Retinal fundus photograph · 45° FOV:
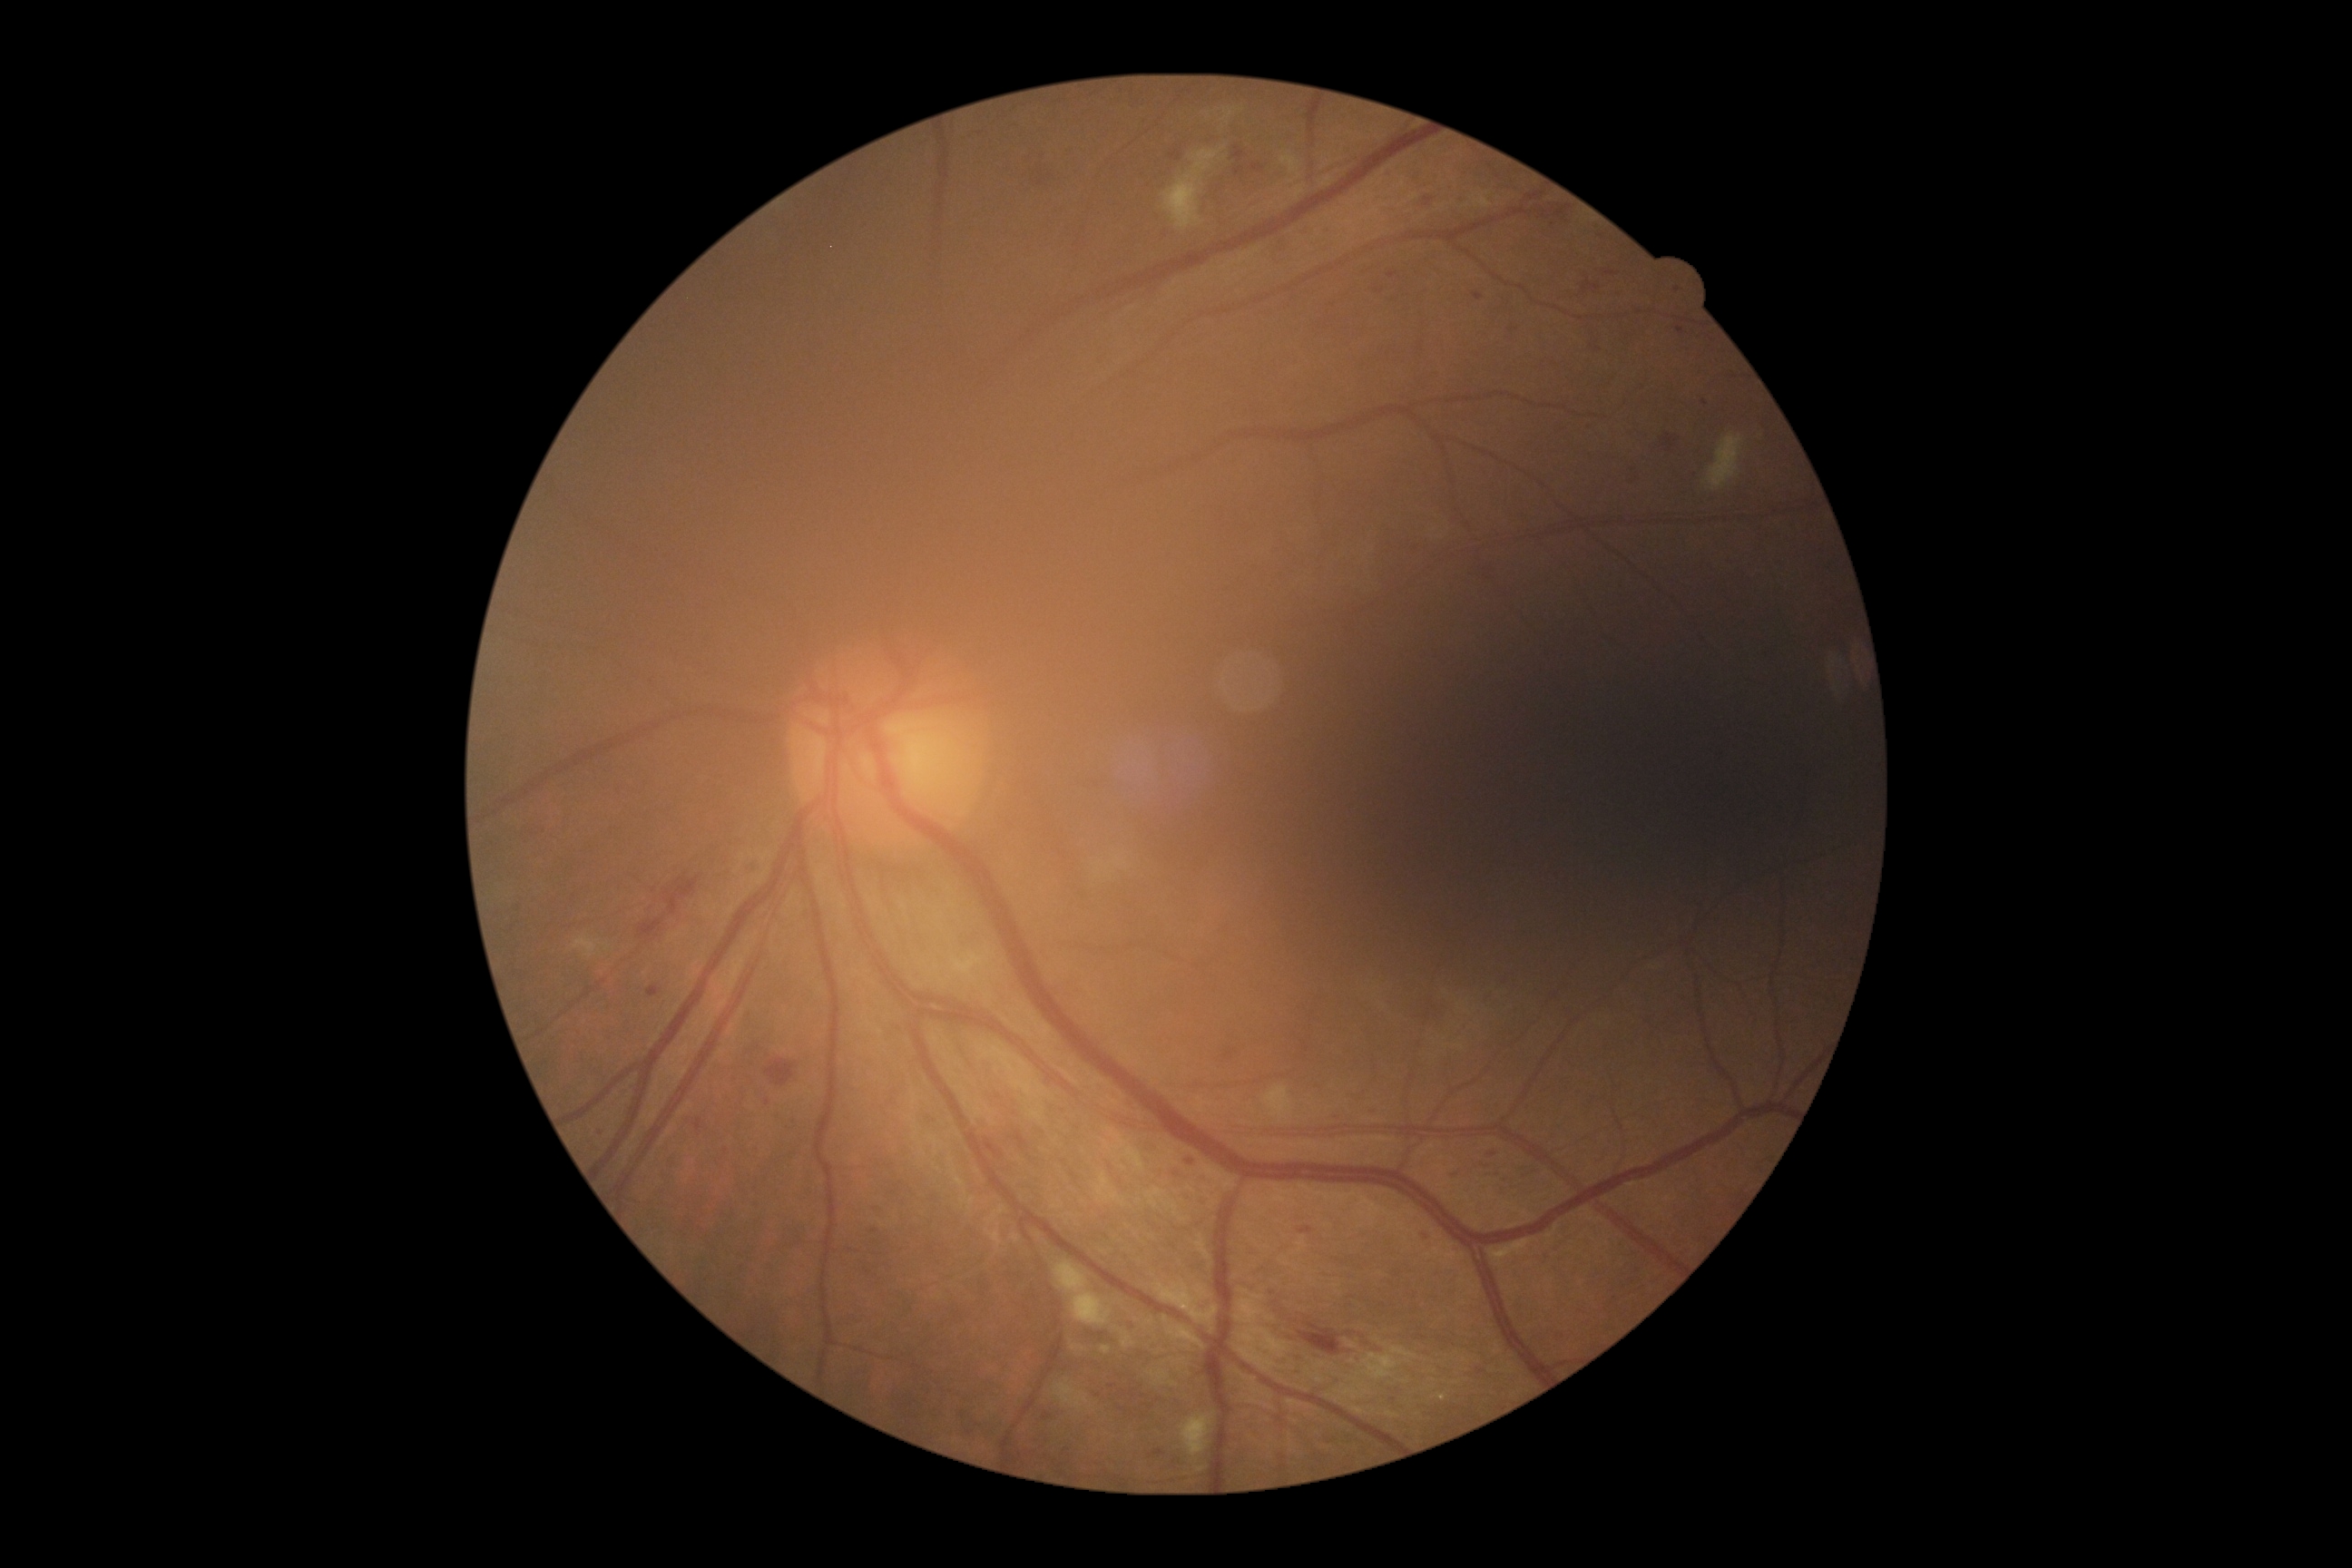 DR grade: 2 (moderate NPDR) — more than just microaneurysms but less than severe NPDR.